Without pupil dilation:
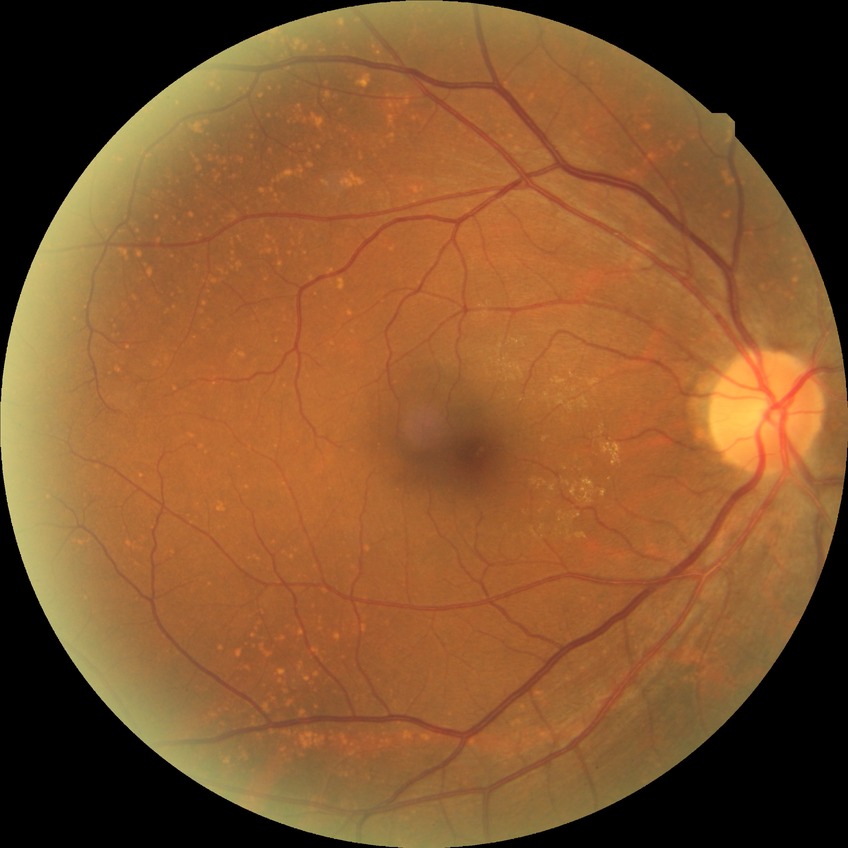
No signs of diabetic retinopathy.
DR stage: NDR.